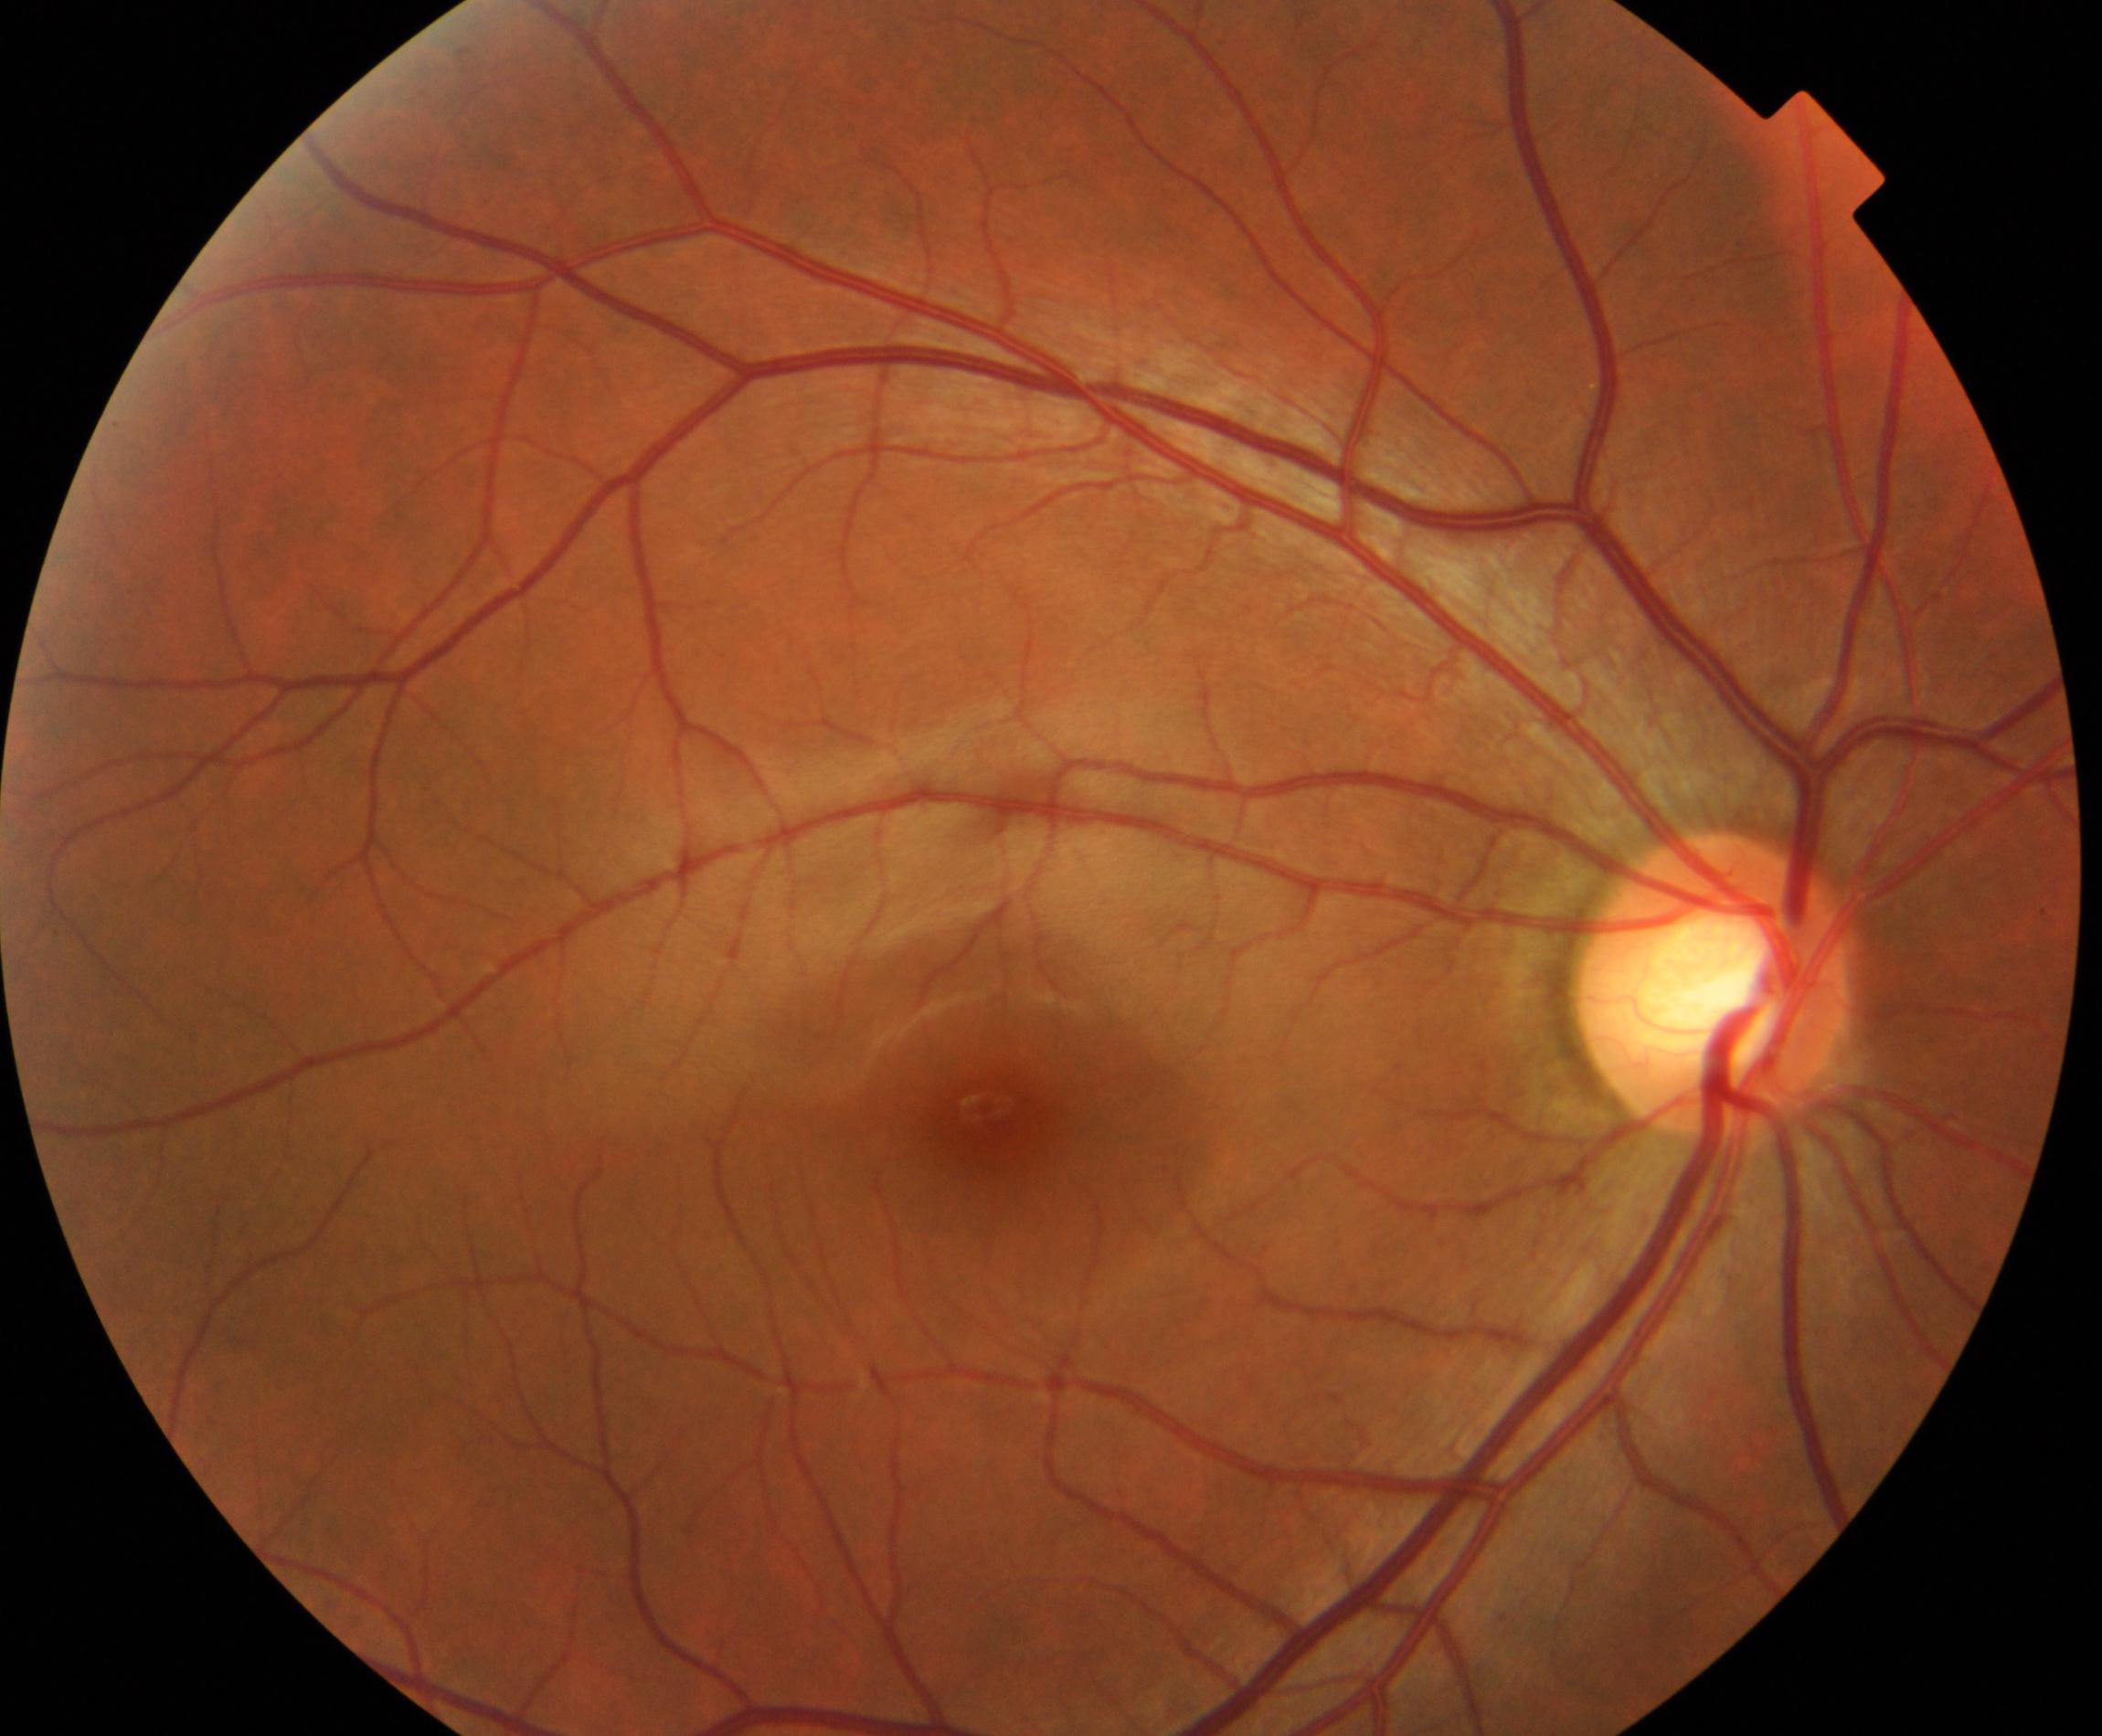 Primary finding: large optic cup.